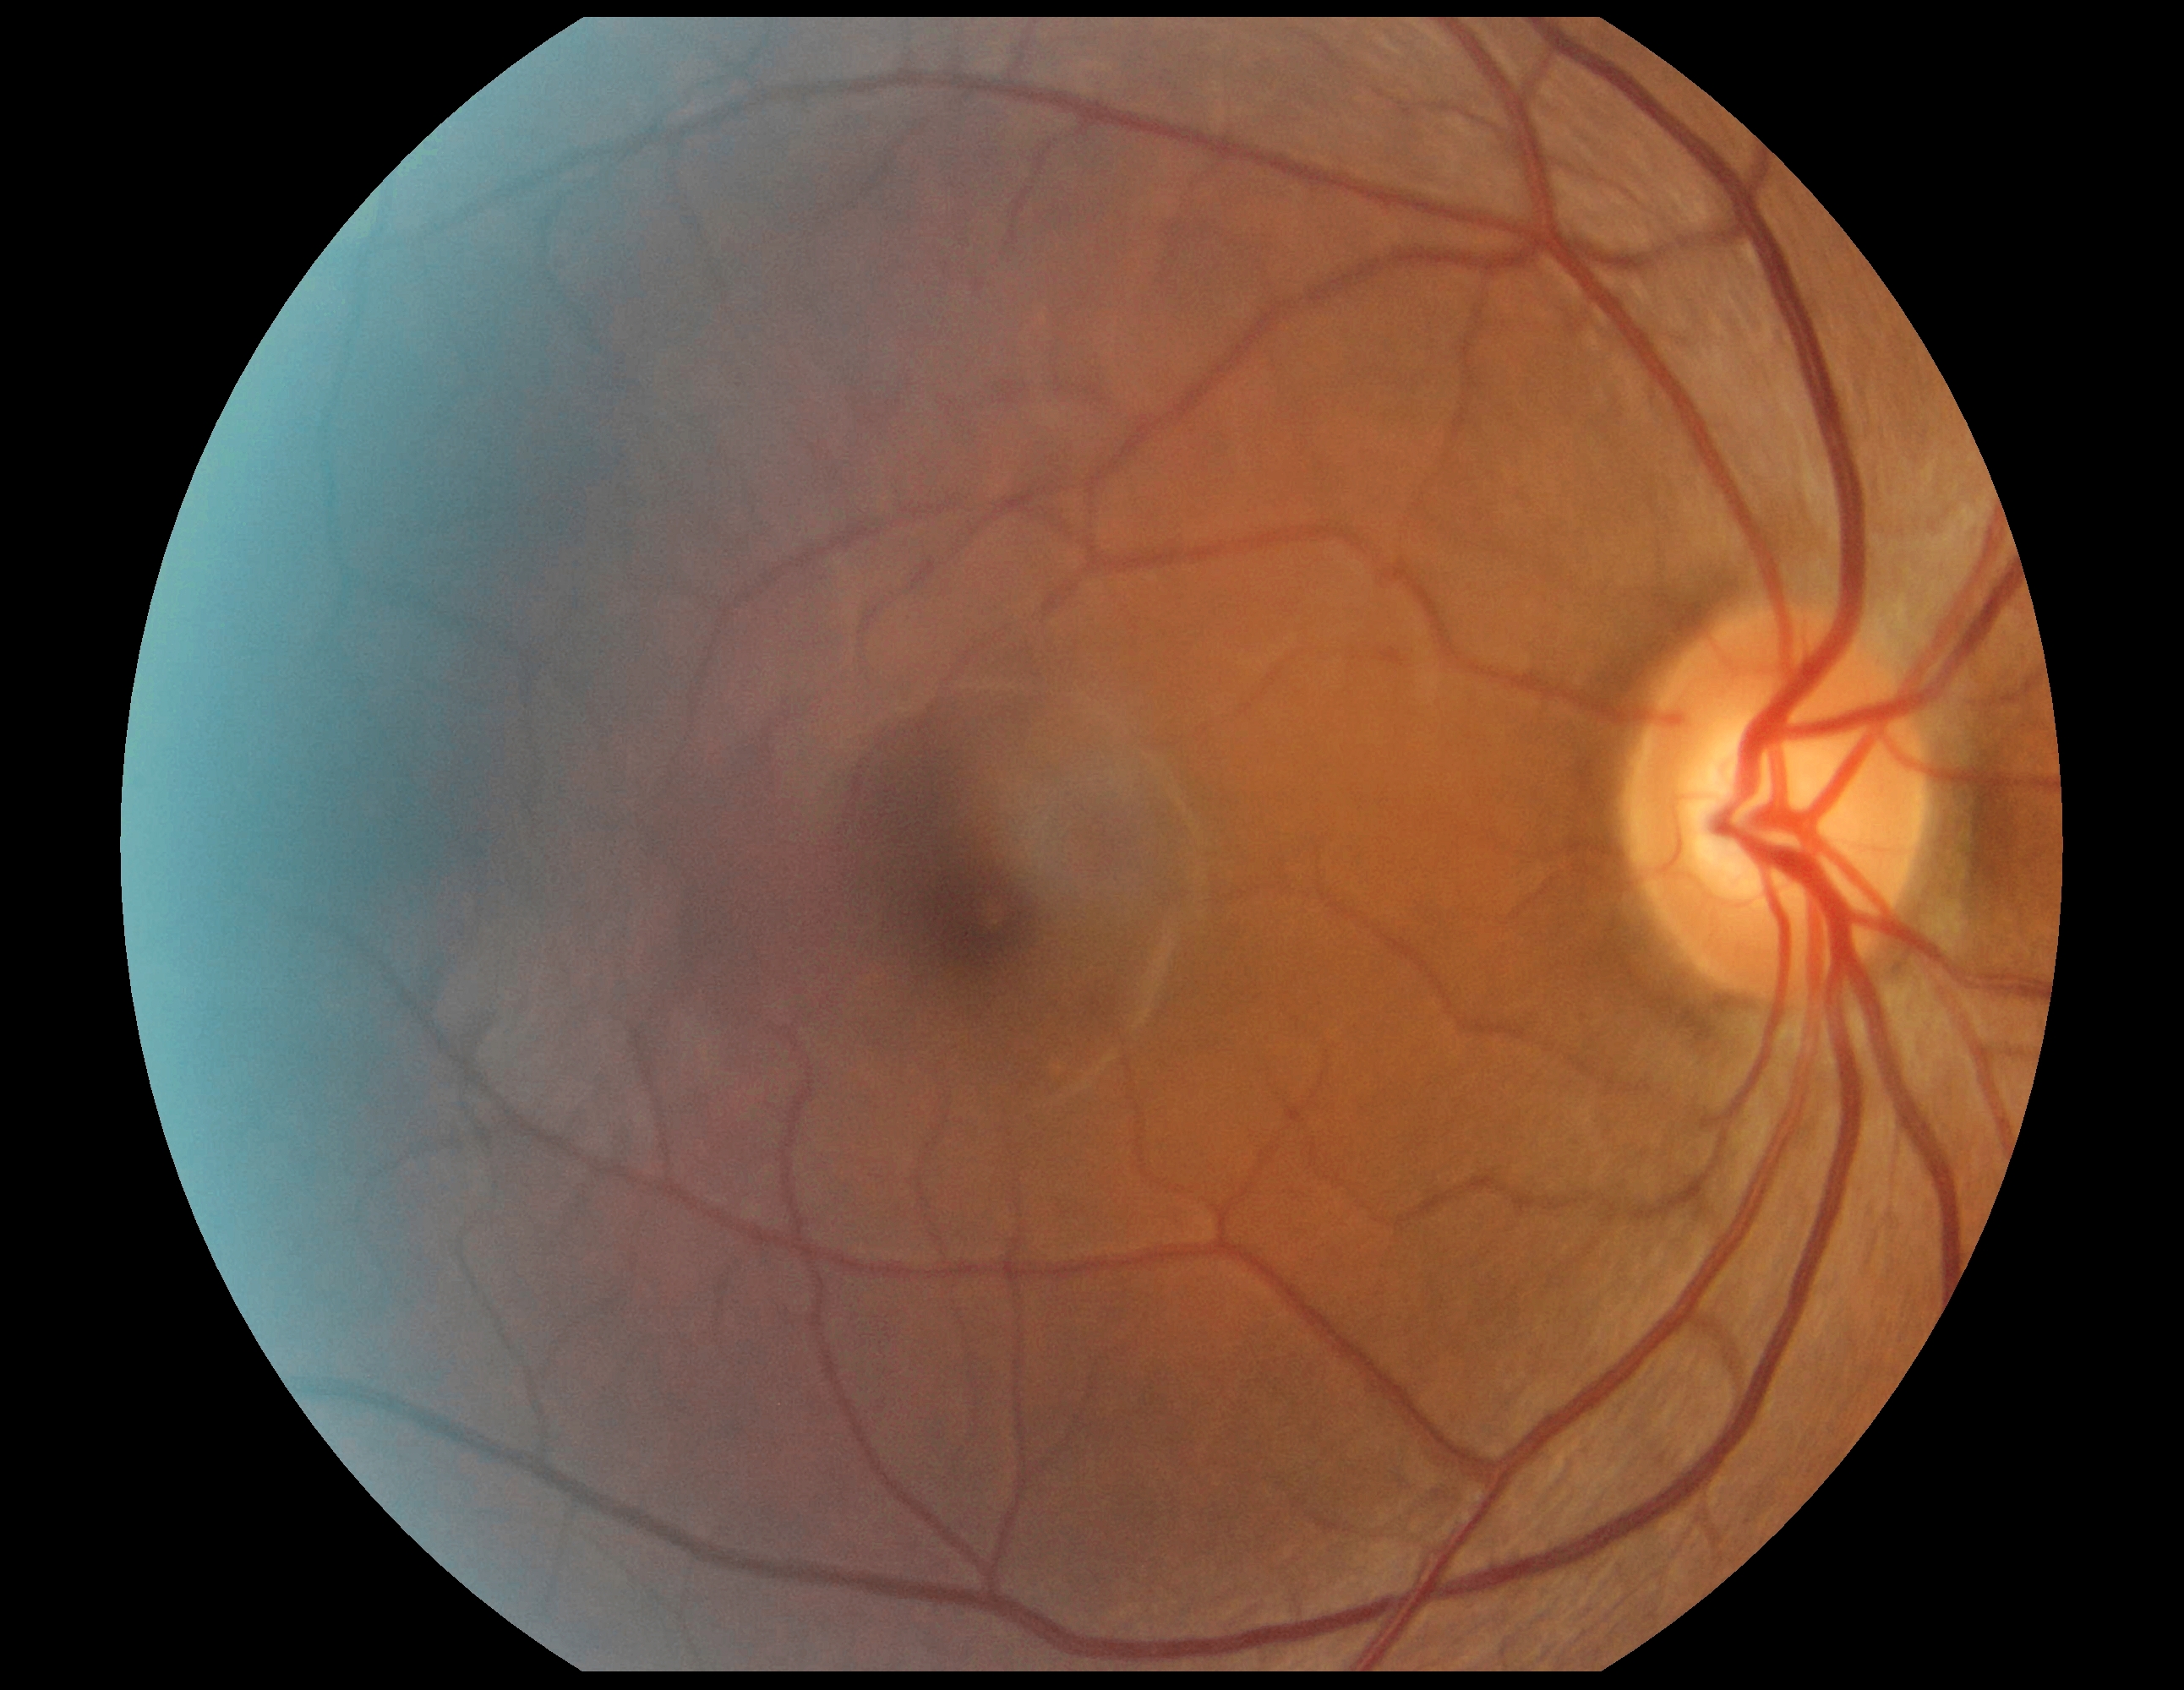 DR stage: no apparent diabetic retinopathy (grade 0).